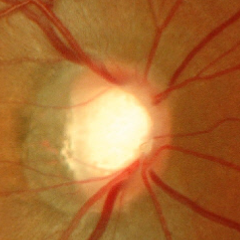
Glaucoma assessment = no glaucomatous changes.